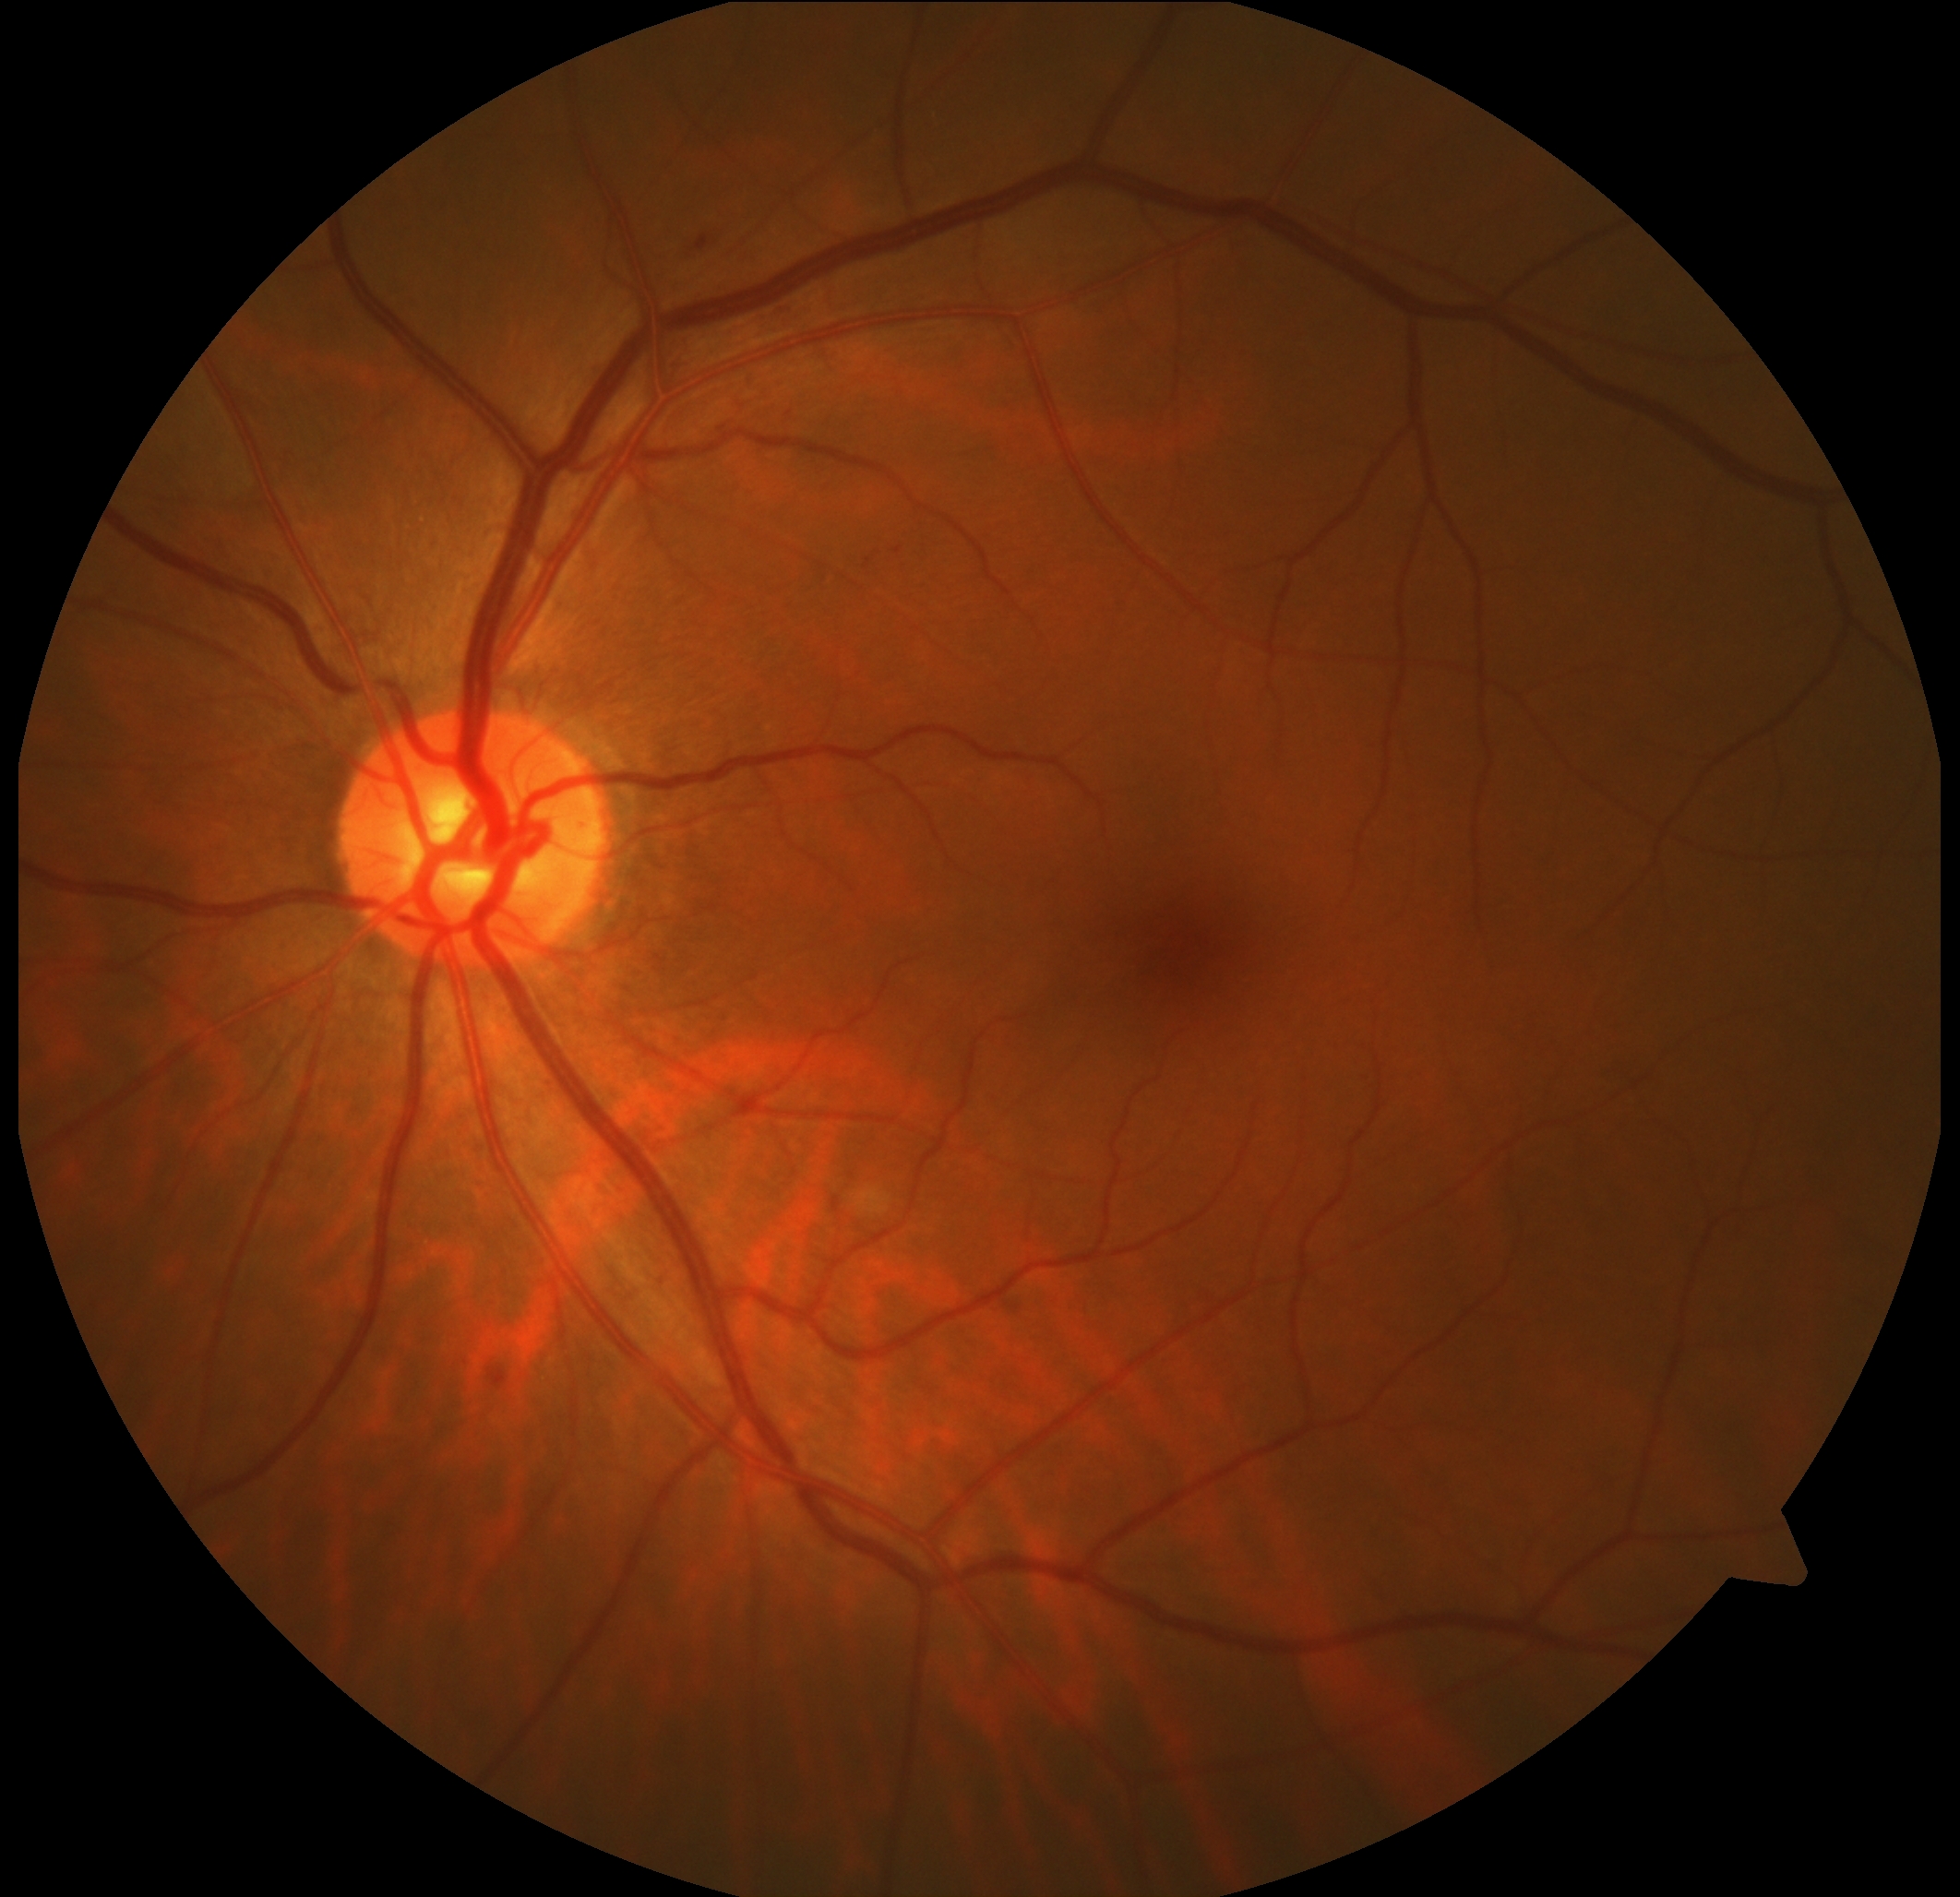 DR stage = grade 2